848 by 848 pixels. Diabetic retinopathy graded by the modified Davis classification. FOV: 45 degrees. Posterior pole photograph. NIDEK AFC-230 fundus camera:
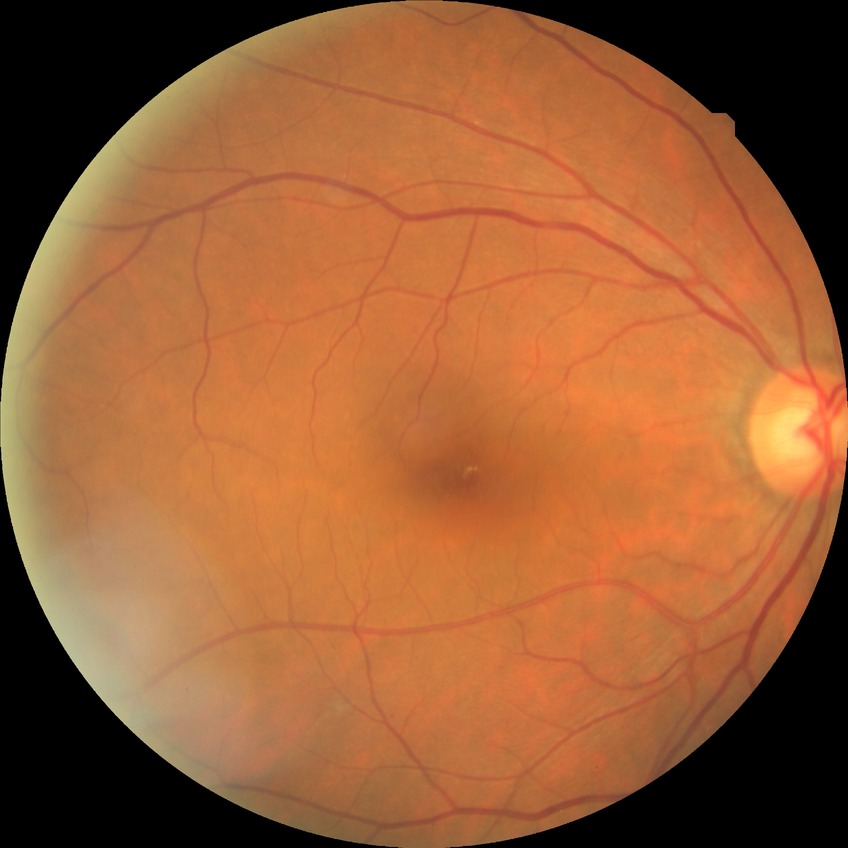

DR is NDR.
No signs of diabetic retinopathy.